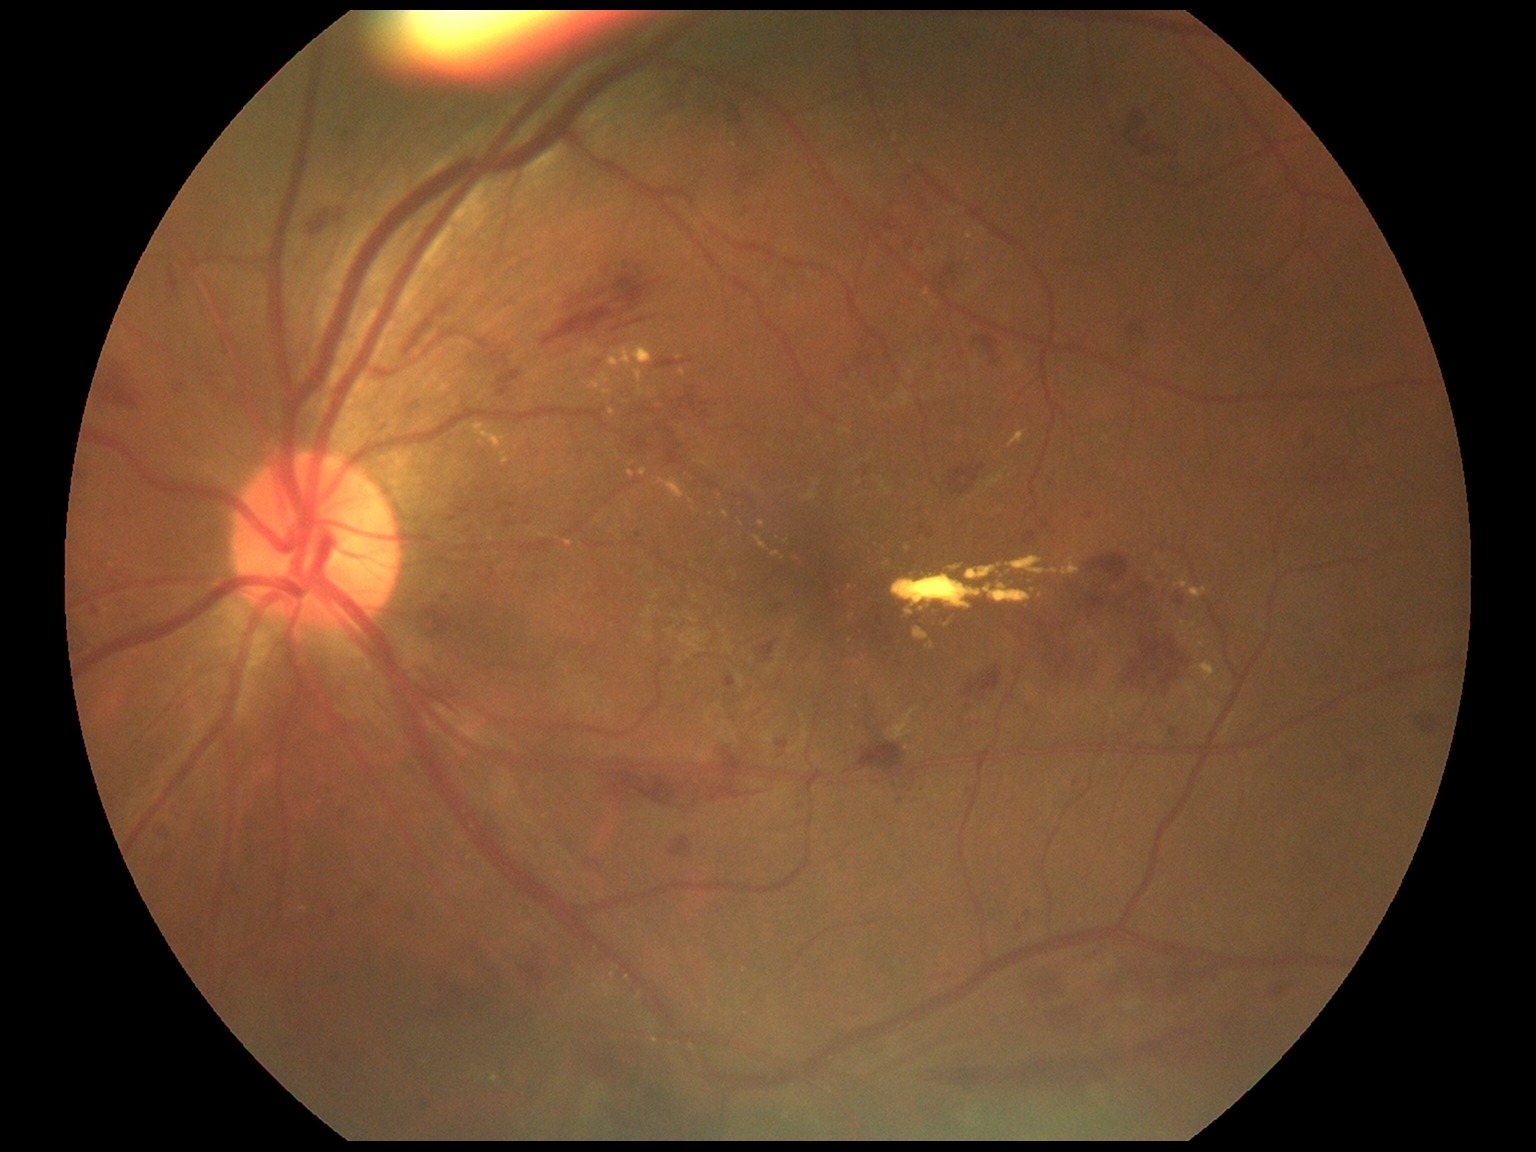 The retinopathy is classified as non-proliferative diabetic retinopathy.
Retinopathy grade is 3.